45 degree fundus photograph; nonmydriatic fundus photograph; fundus photo:
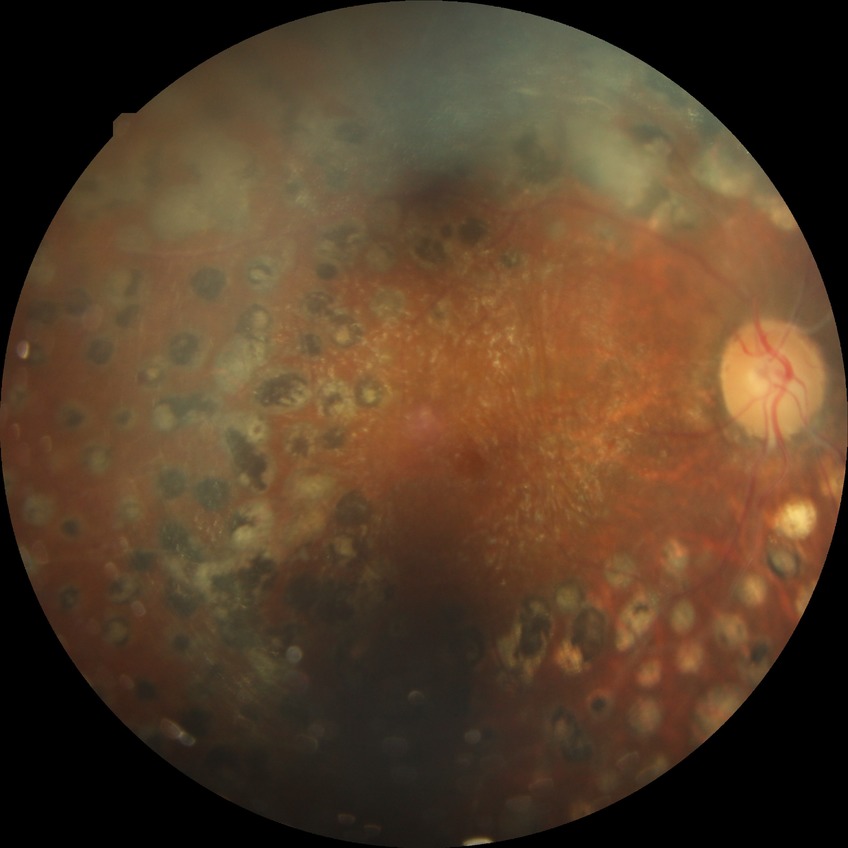 DR grade: PDR.